Color fundus image; FOV: 45 degrees: 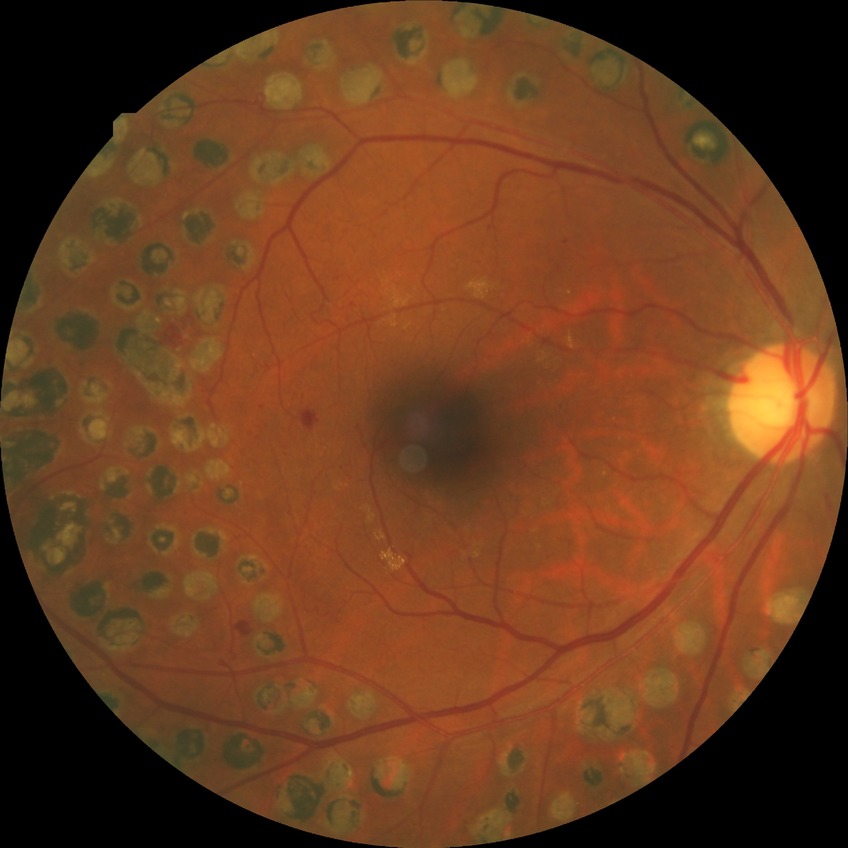

Diabetic retinopathy (DR): proliferative diabetic retinopathy (PDR).